Pediatric wide-field fundus photograph
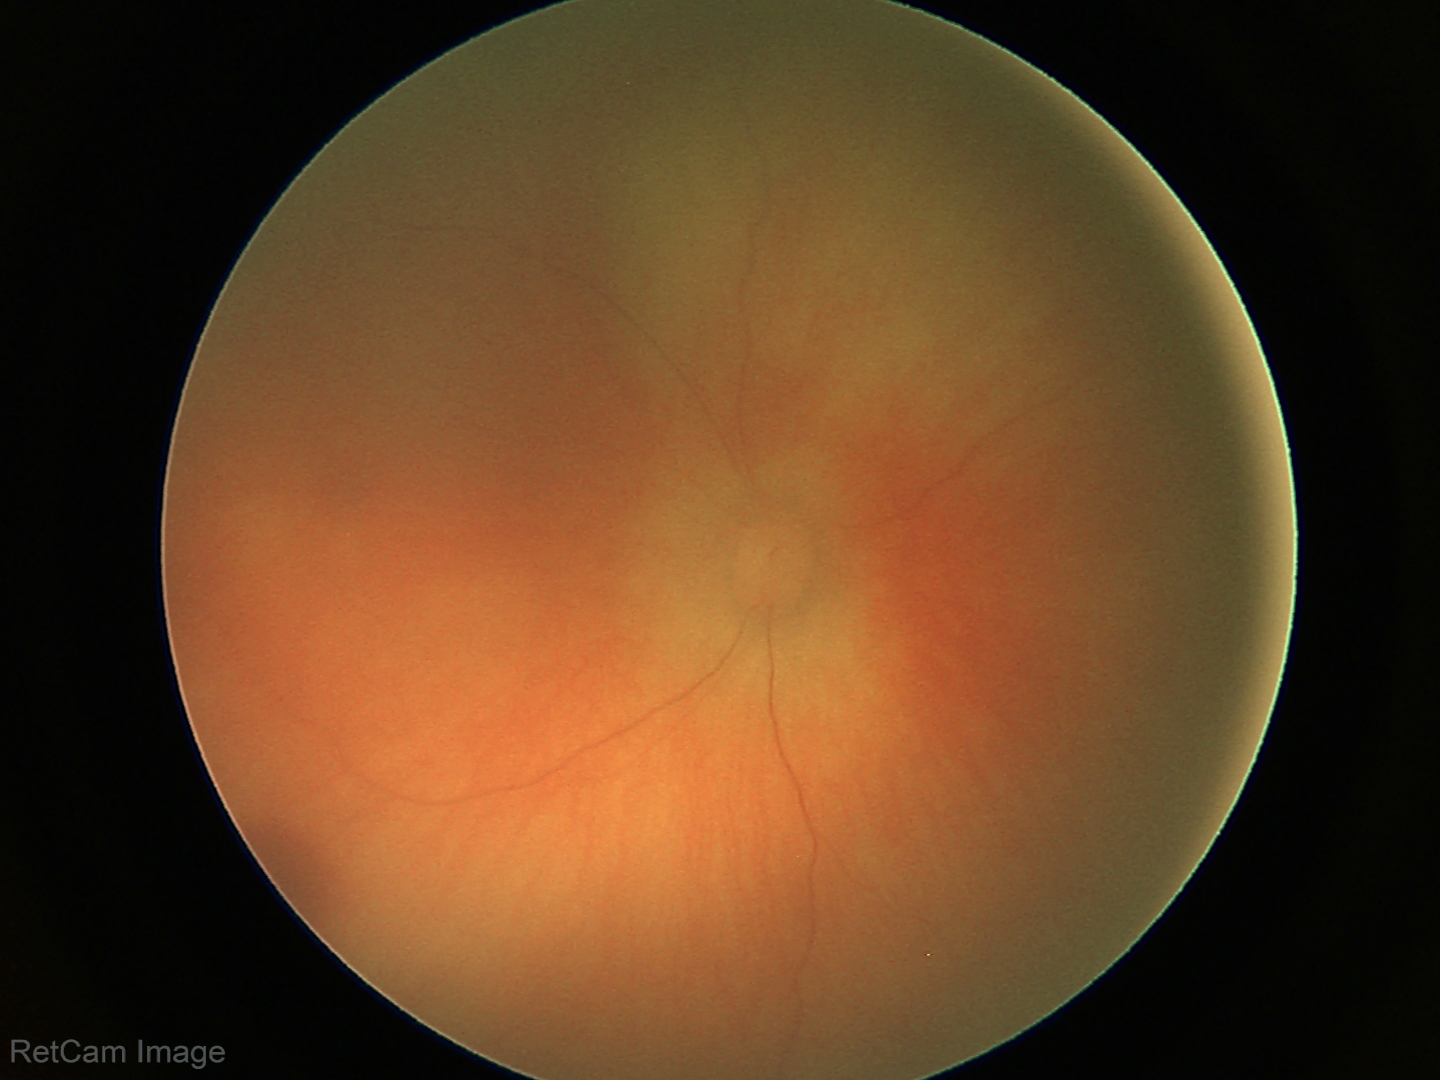

Examination diagnosed as retinal hemorrhages.